Infant wide-field retinal image — 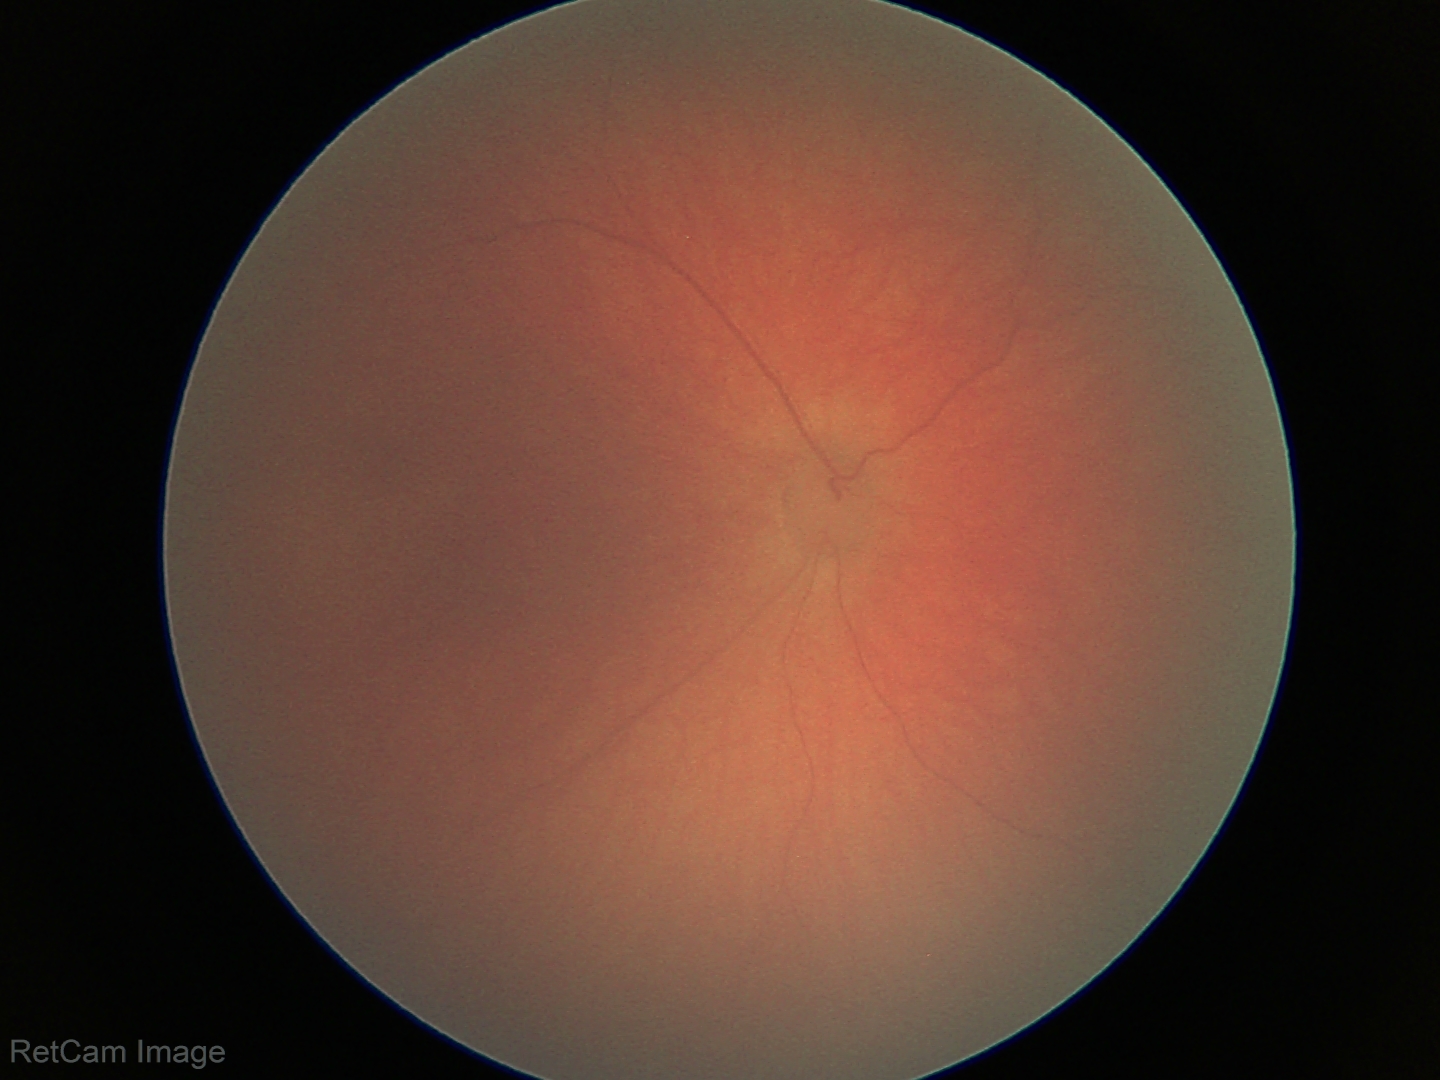

Physiological retinal appearance for postconceptual age.